CFP, non-mydriatic acquisition, camera: Nidek AFC-330:
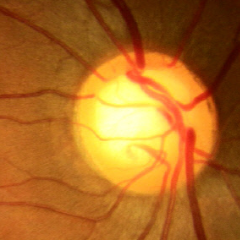 Glaucoma status: no glaucomatous changes.